Infant wide-field retinal image. 640 by 480 pixels. Acquired on the Clarity RetCam 3
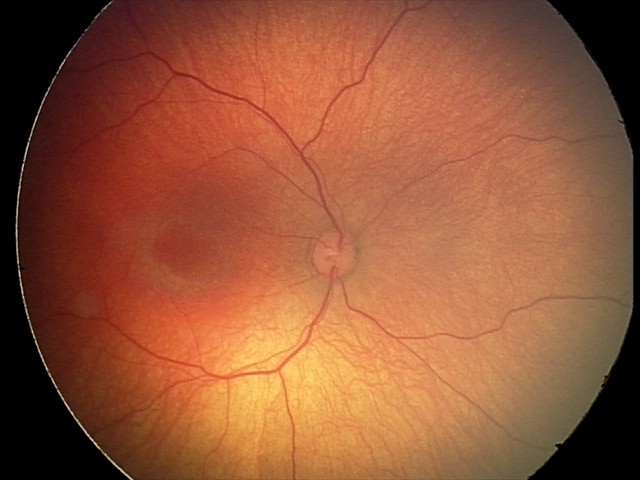
No retinal pathology identified on screening.